Fundus photo.
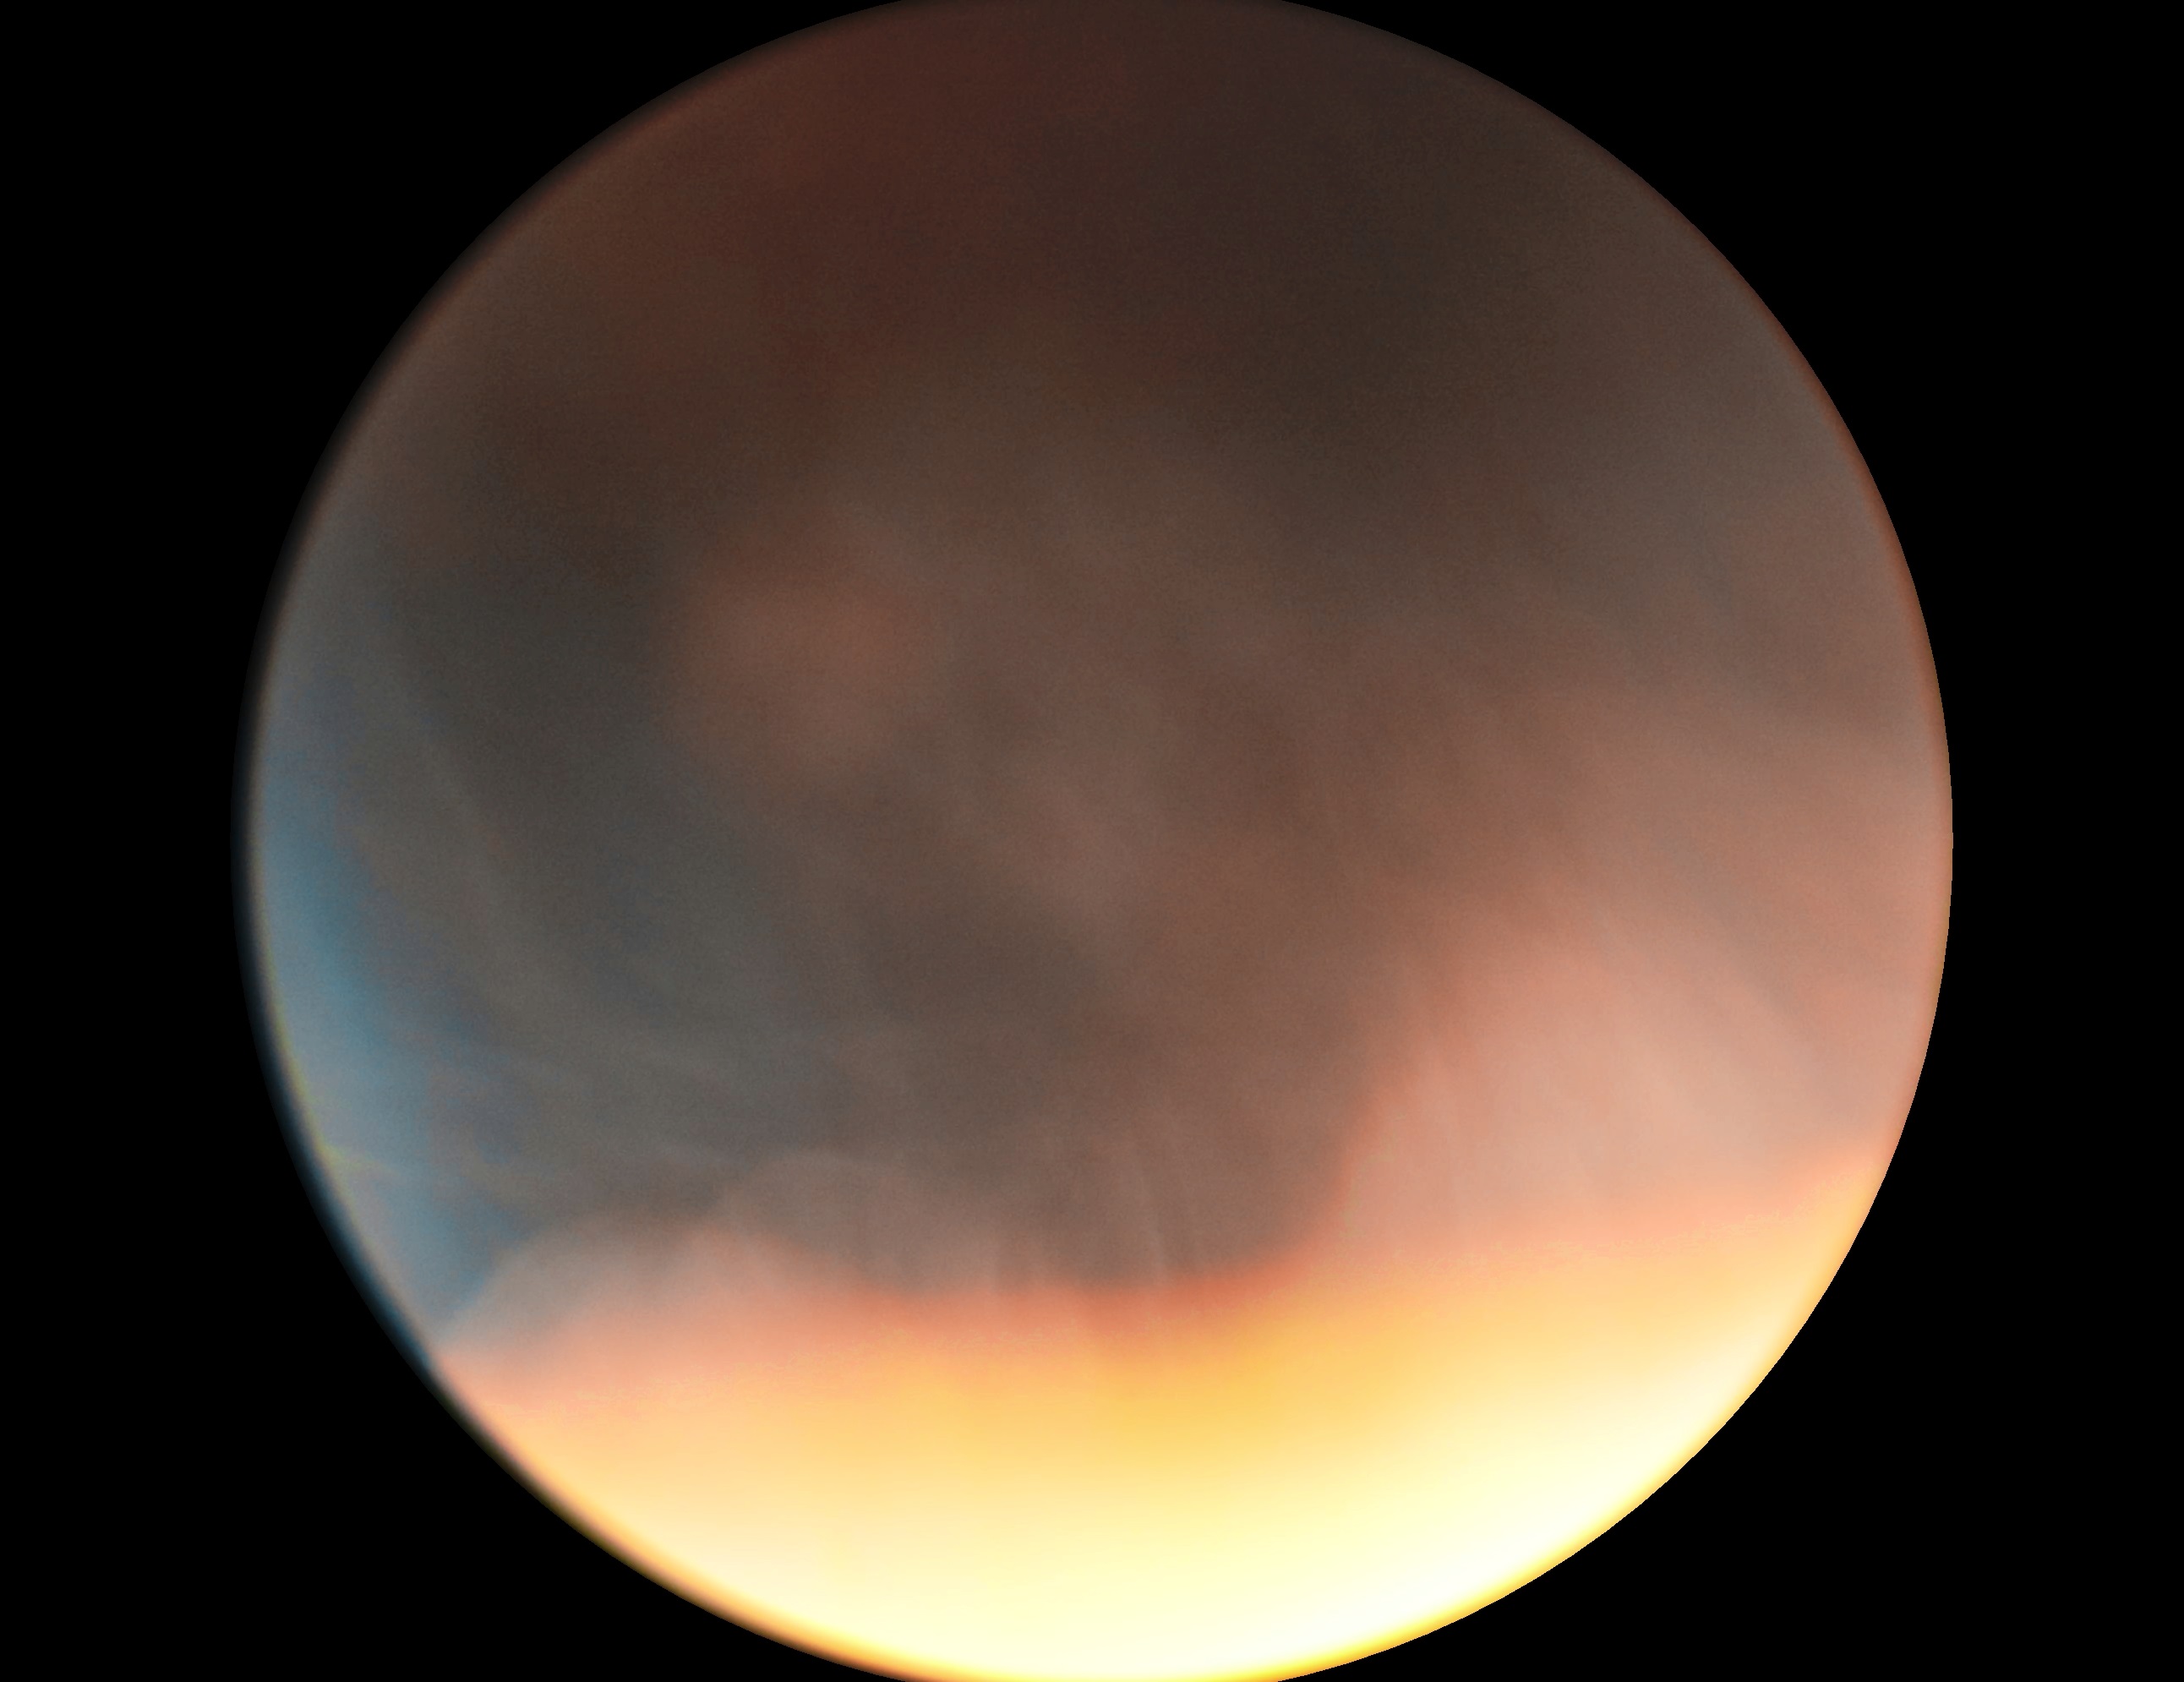

Findings:
• DR — ungradable